DR severity per modified Davis staging
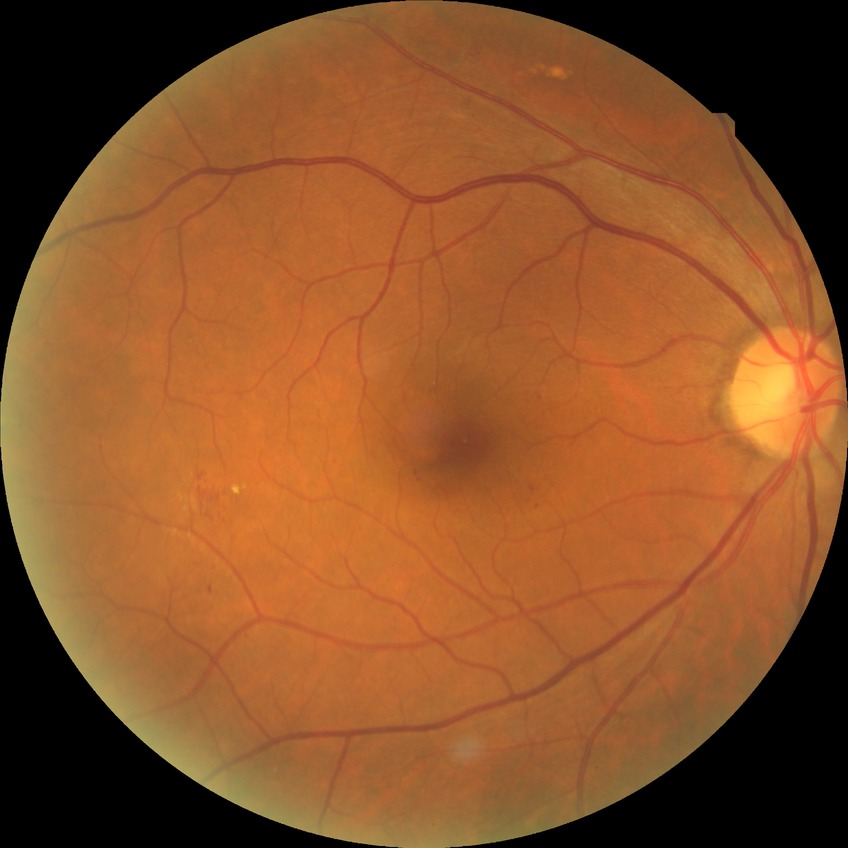
  davis_grade: simple diabetic retinopathy